45° field of view. CFP
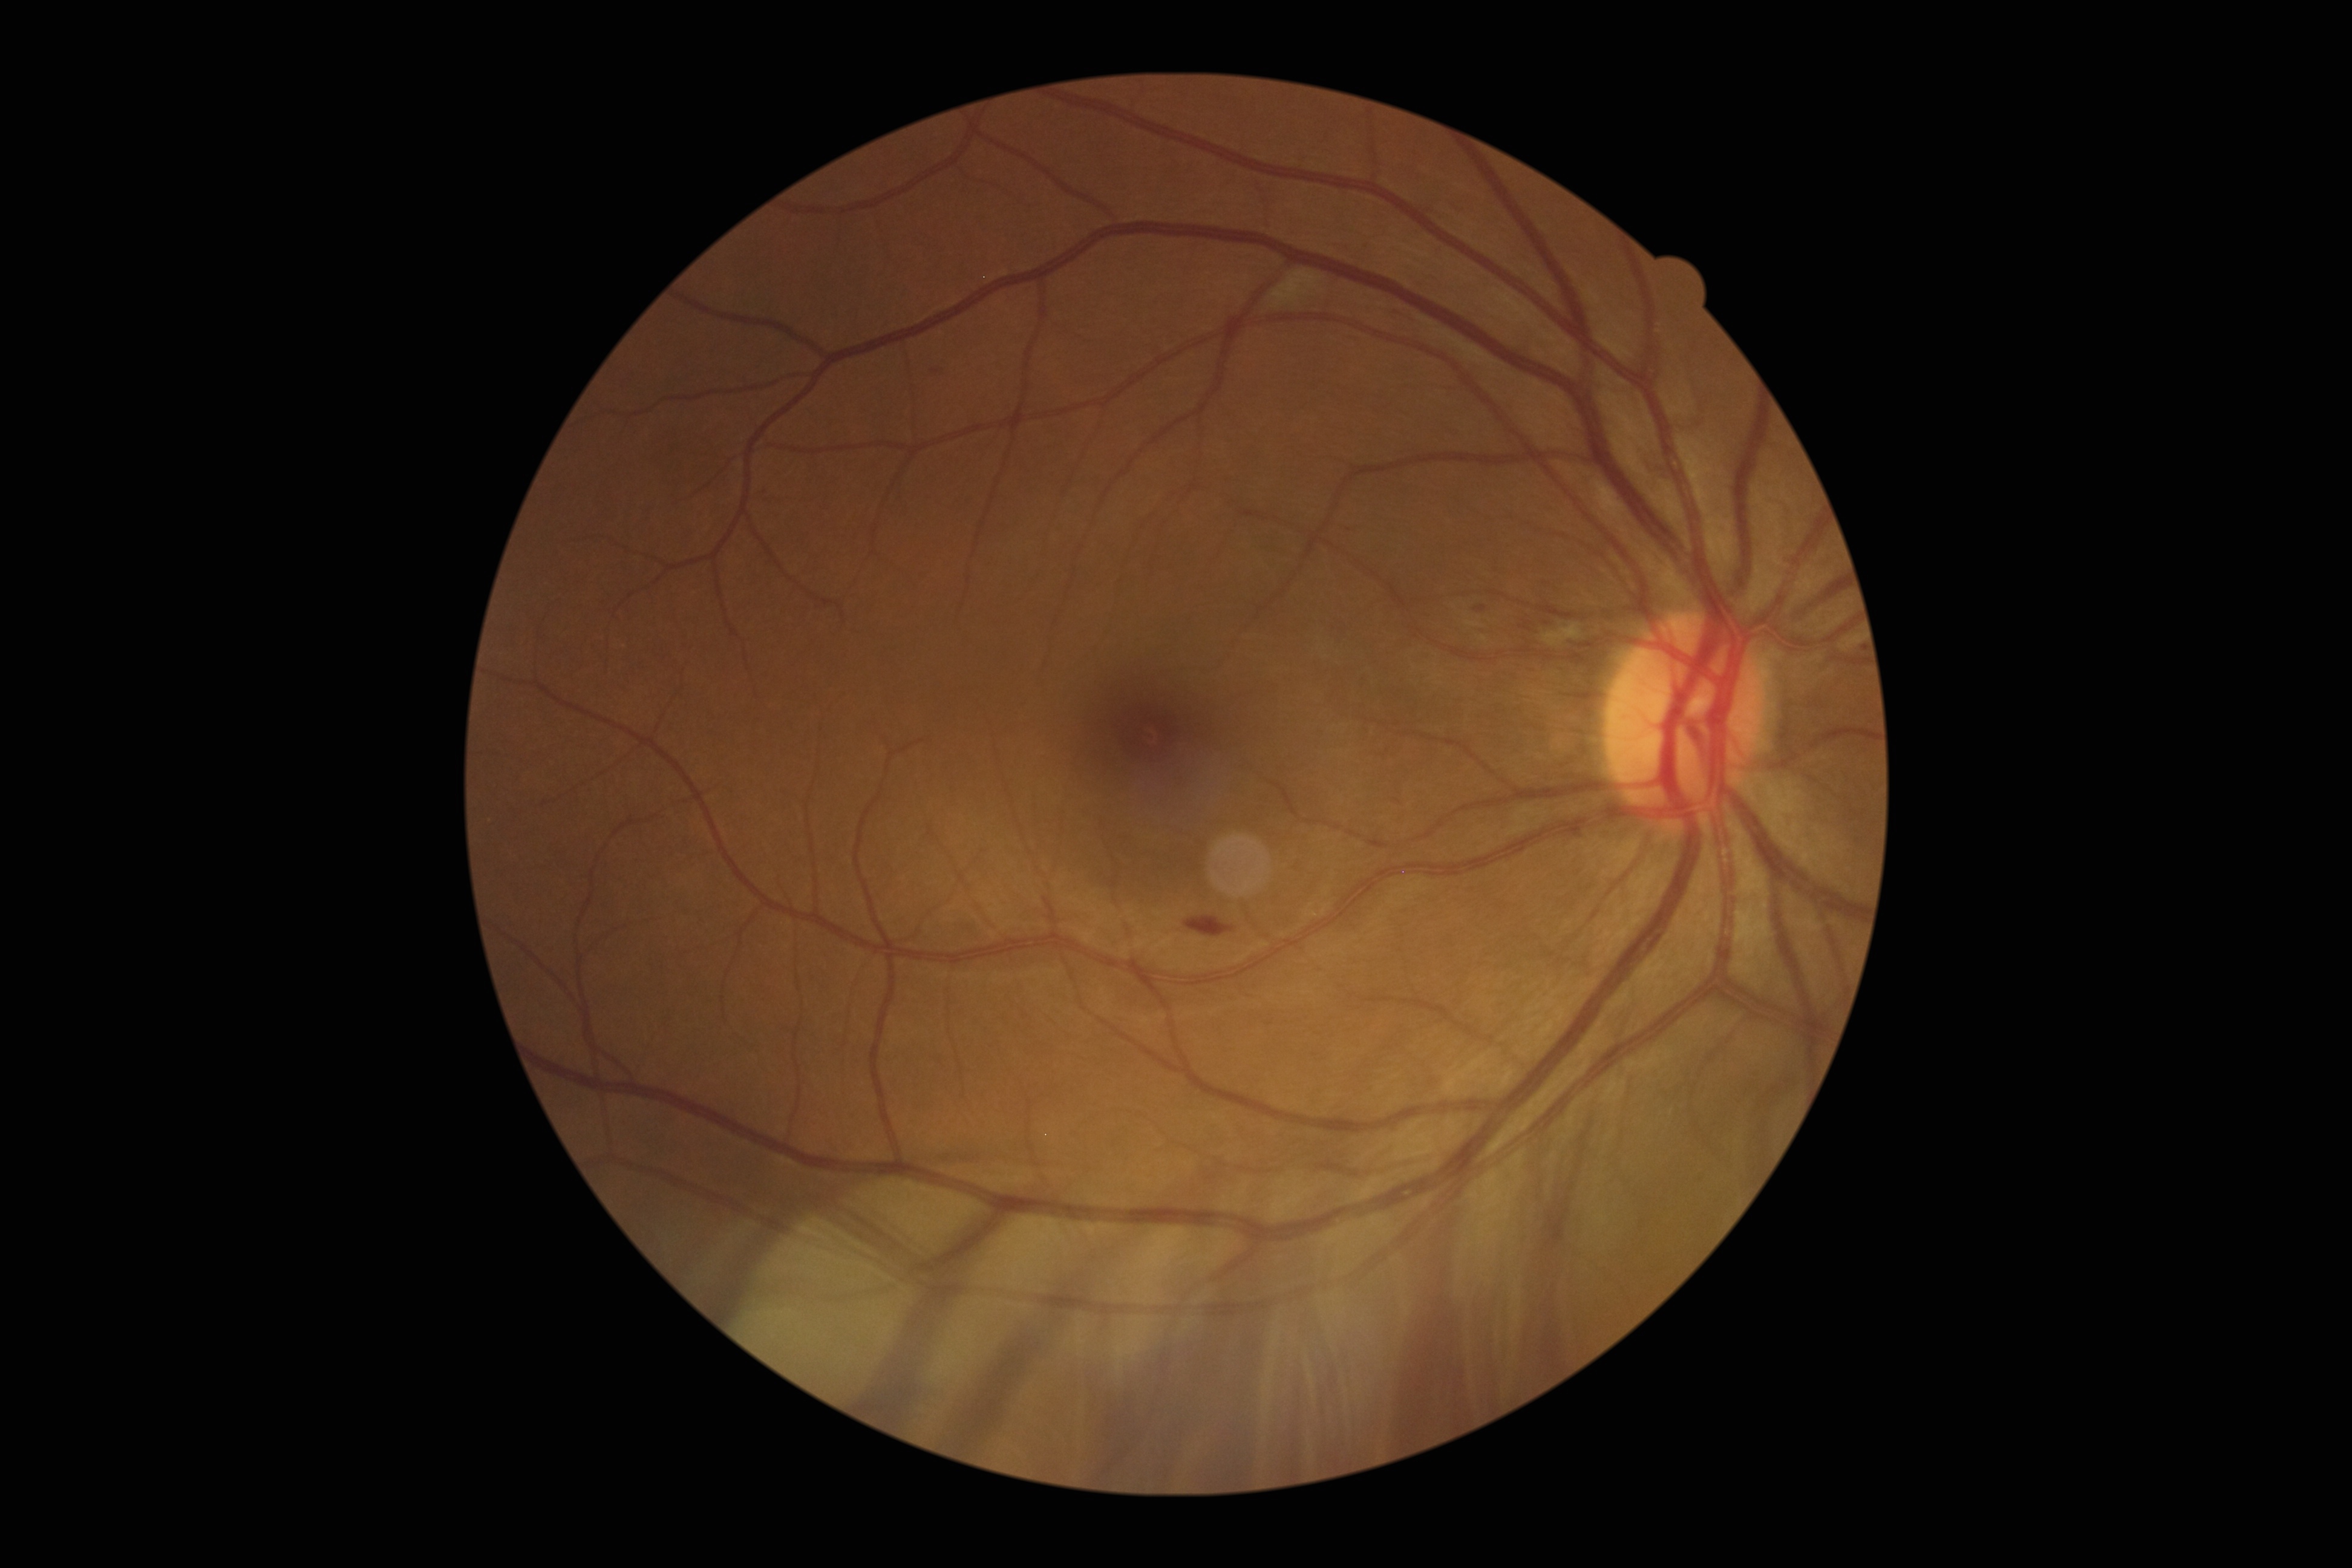

Disease class: non-proliferative diabetic retinopathy.
Retinopathy is grade 2.